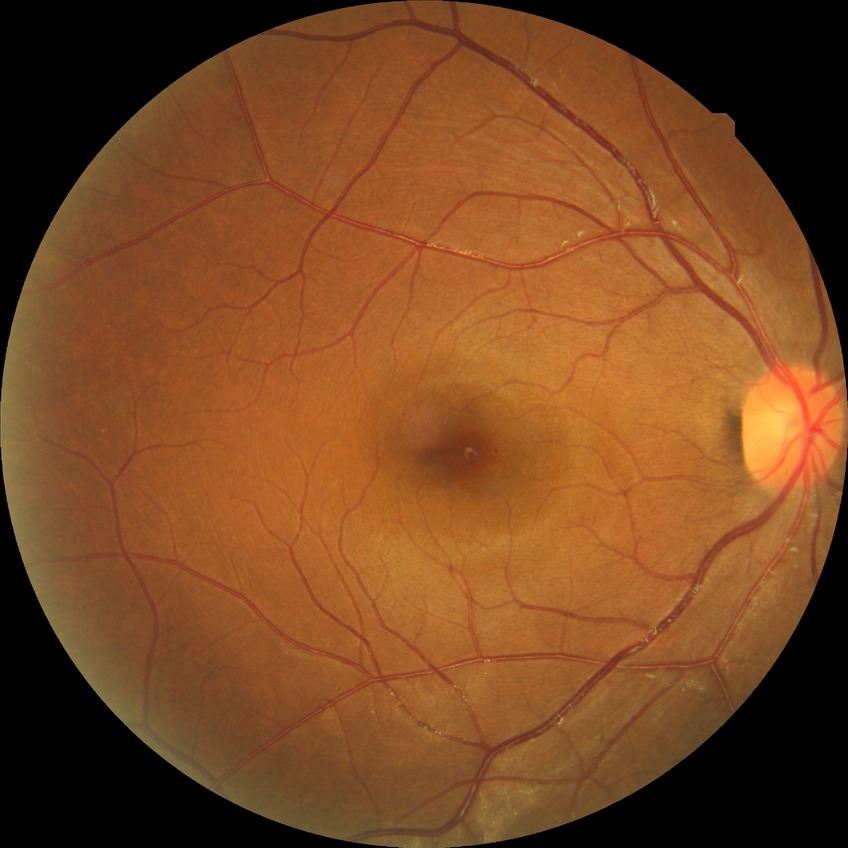
Davis grading is no diabetic retinopathy.